45° field of view
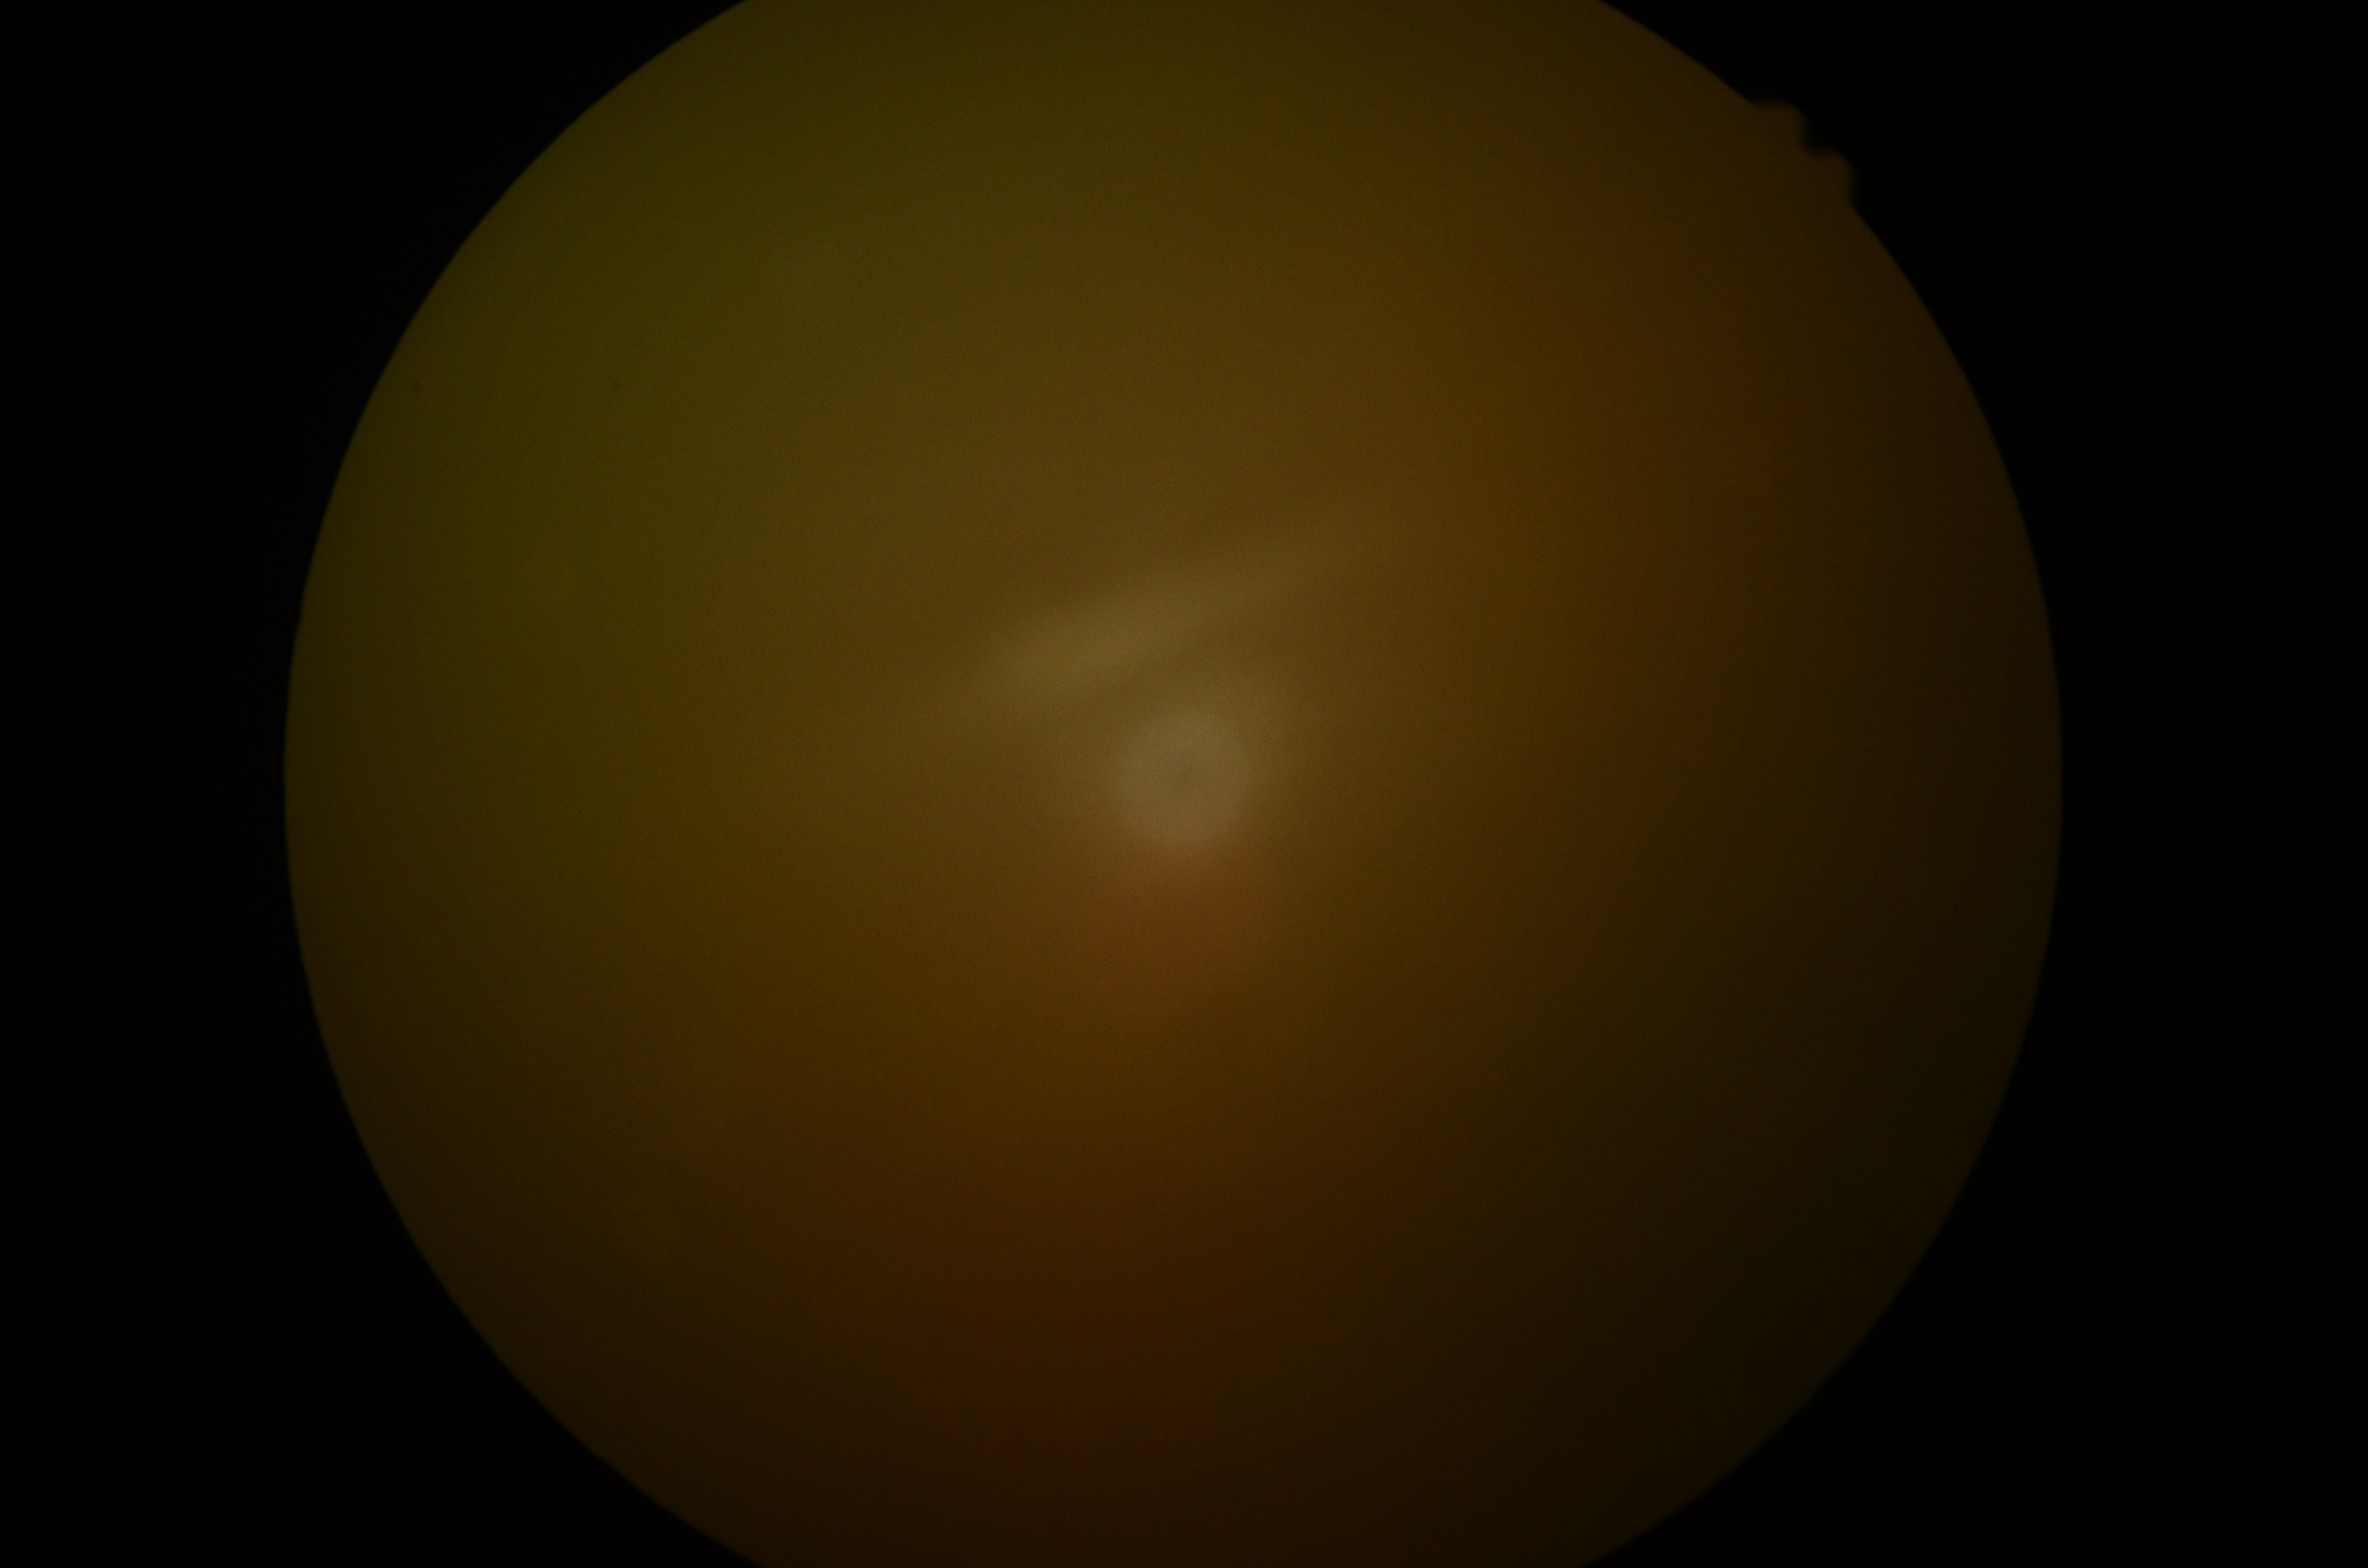
{"dr_grade": "ungradable"}